45-degree field of view · 2352 by 1568 pixels · retinal fundus photograph.
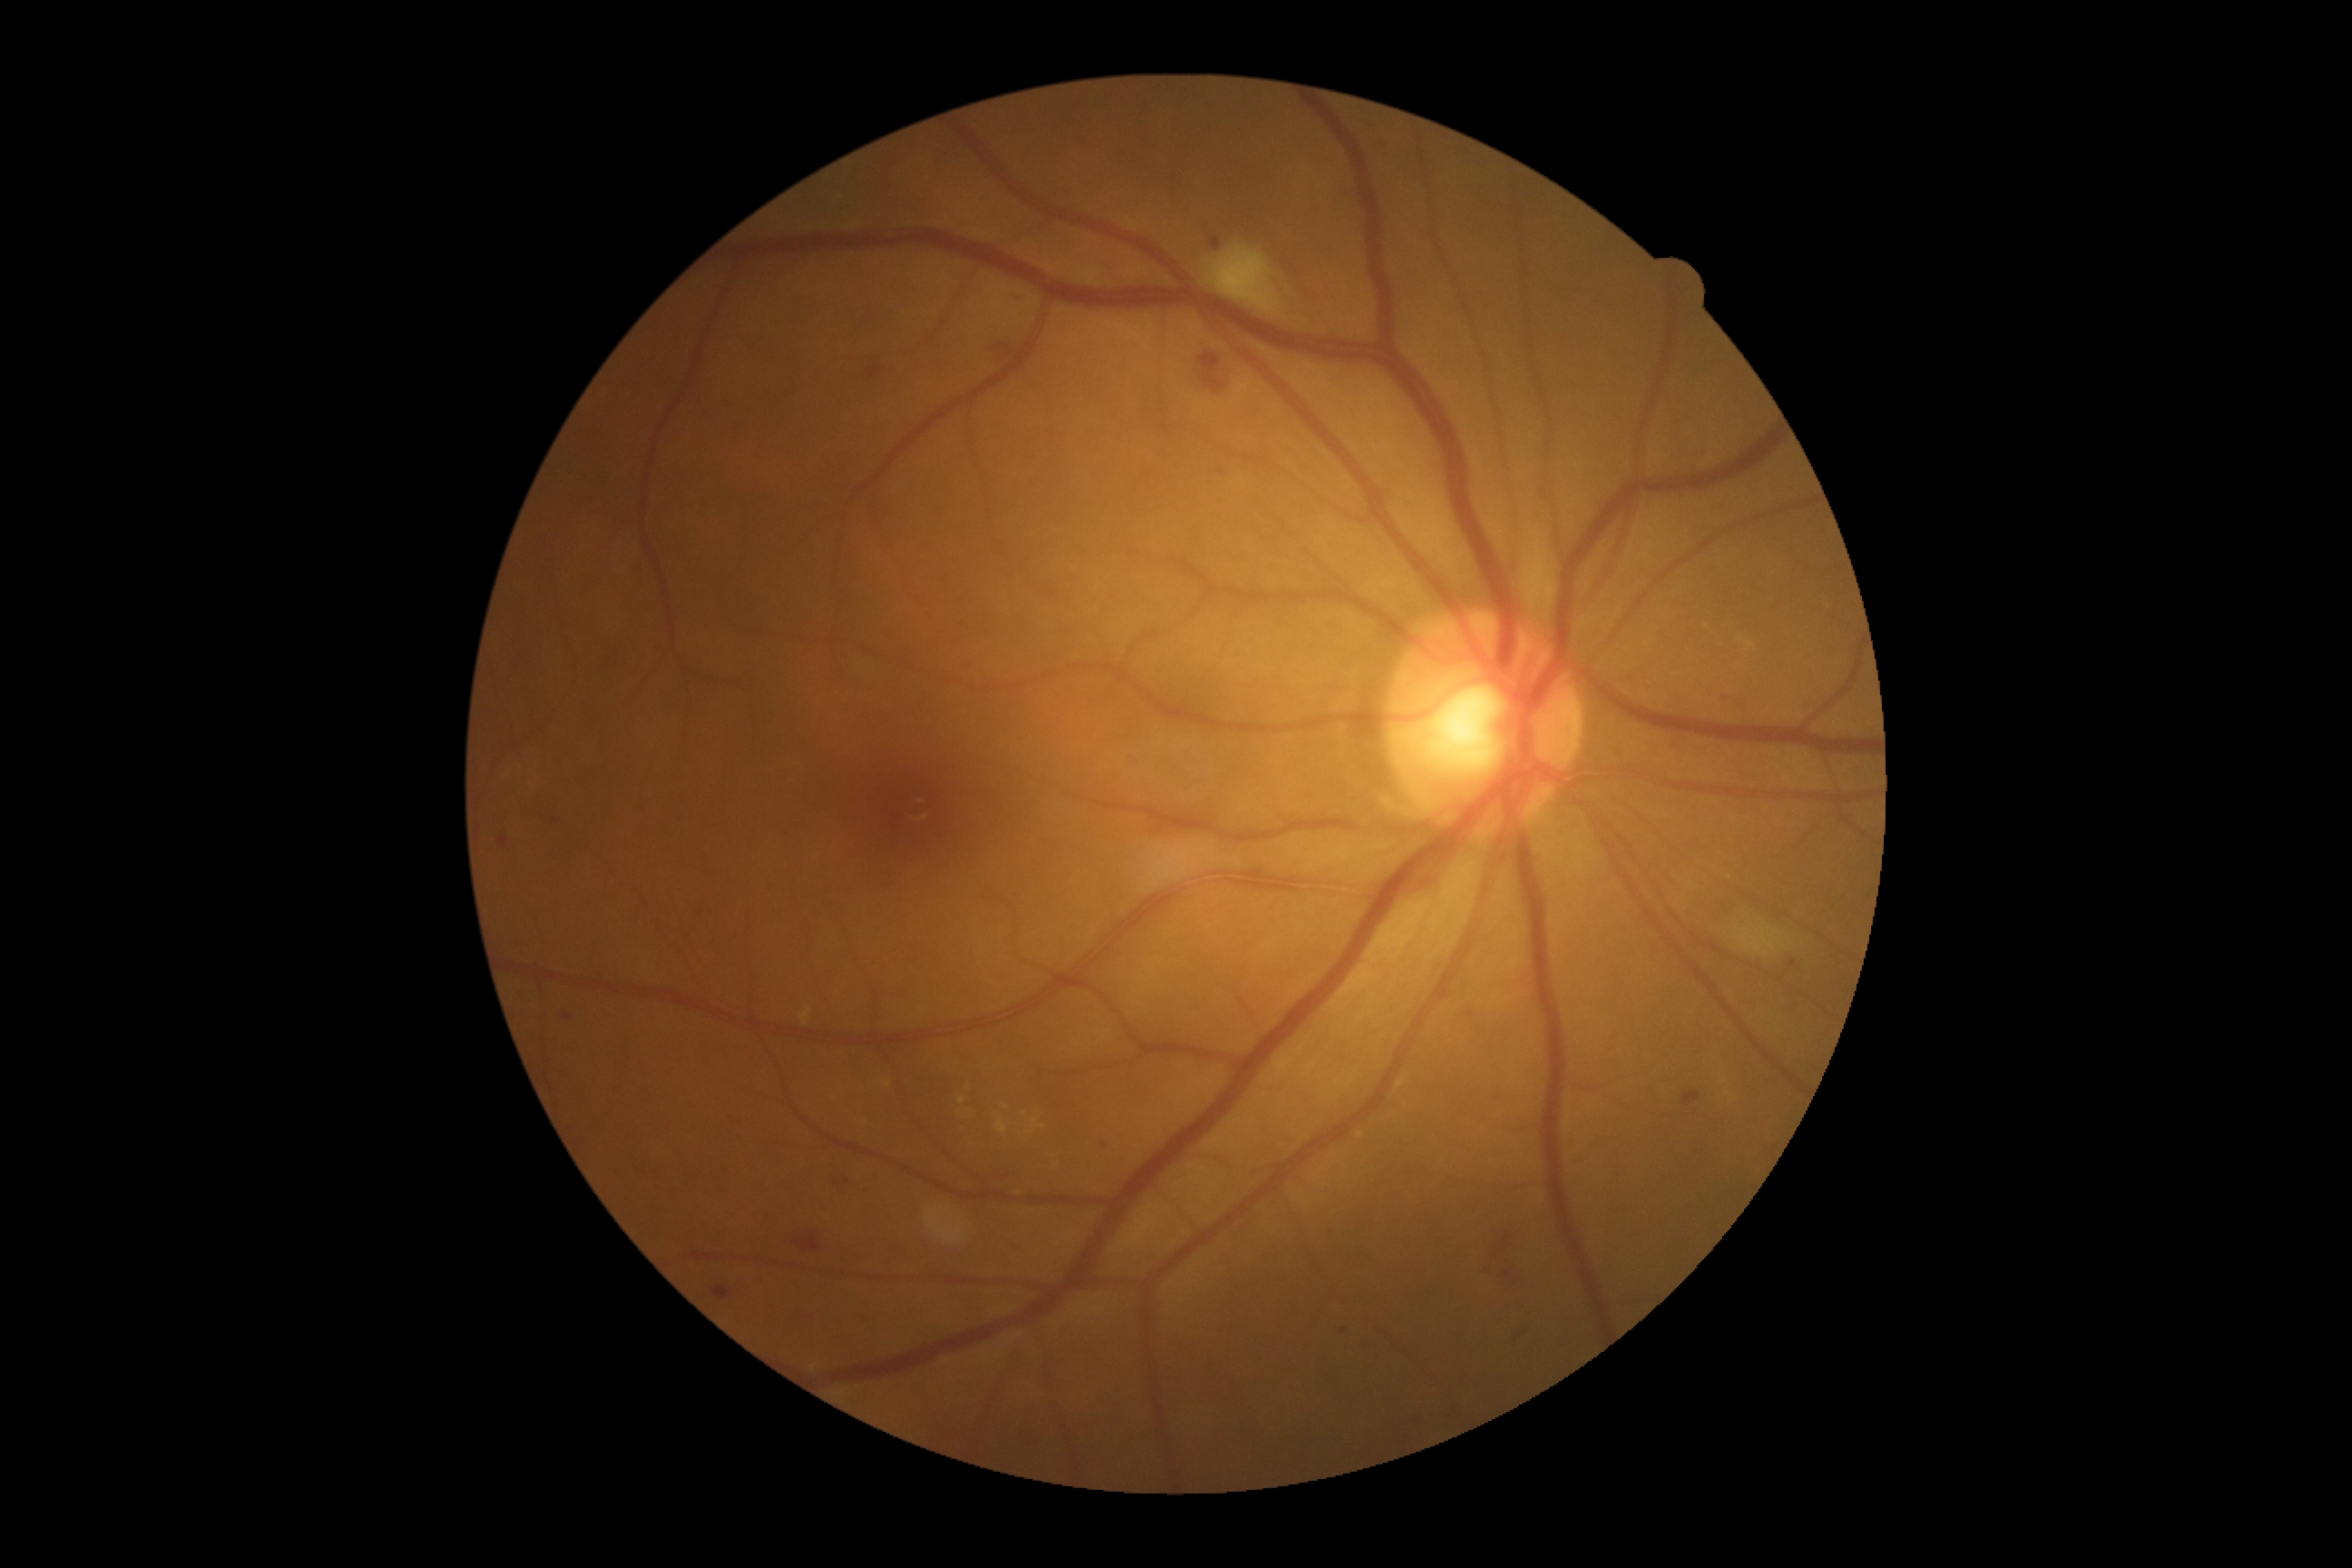
DR severity is 2 — more than just microaneurysms but less than severe NPDR. Disease class: non-proliferative diabetic retinopathy.